Camera: Topcon TRC-50DX, captured after pupil dilation, 2228x1652px, color fundus image, central posterior field.
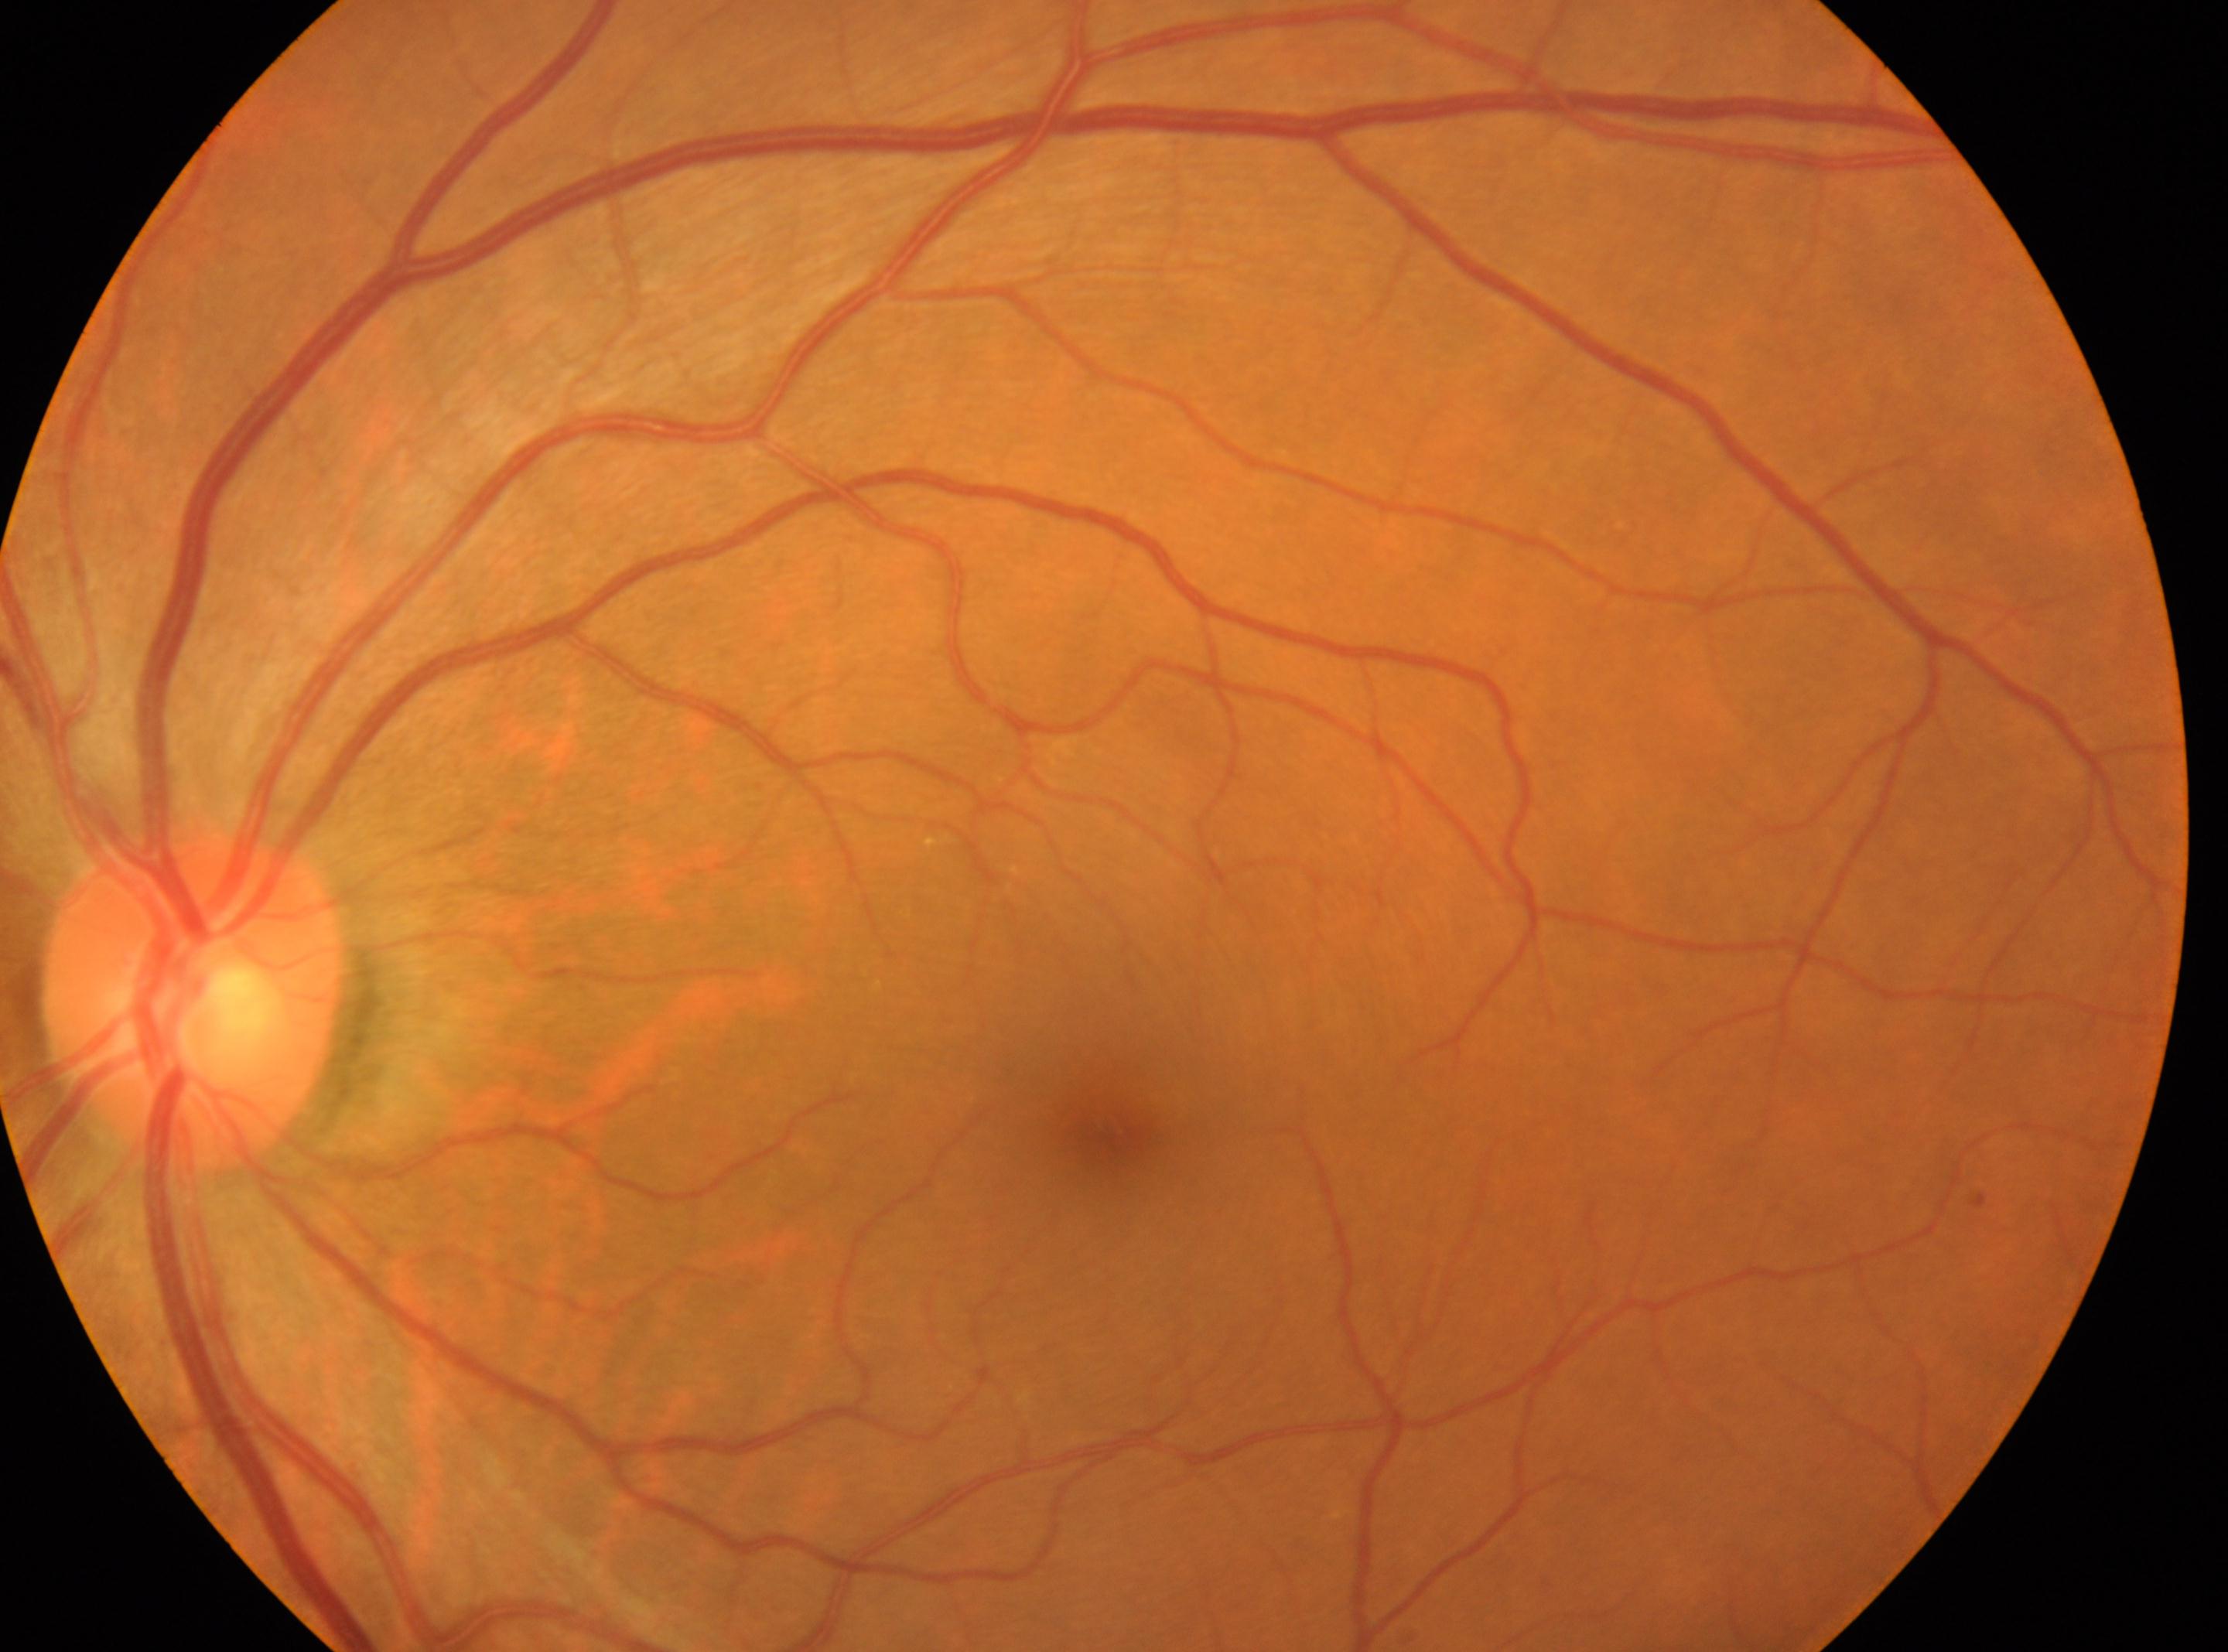
• laterality: the left eye
• DR severity: 0
• ONH: (x: 192, y: 999)
• fovea: (x: 1109, y: 1126)